Retinal fundus photograph, NIDEK AFC-230 fundus camera
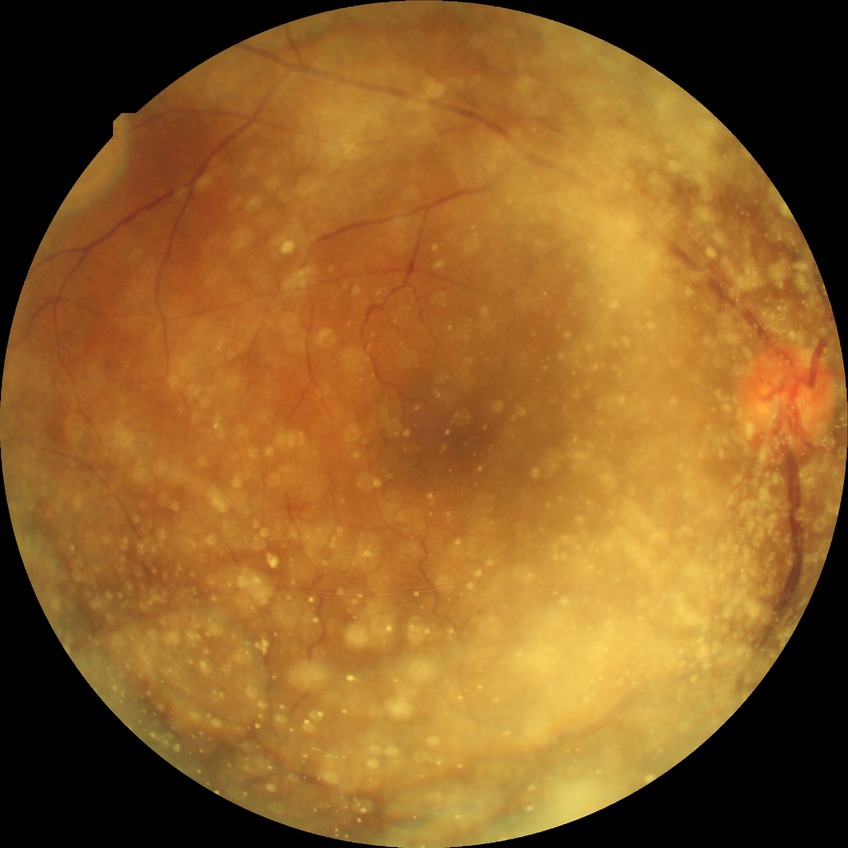

Davis stage: NDR.
No DR findings.